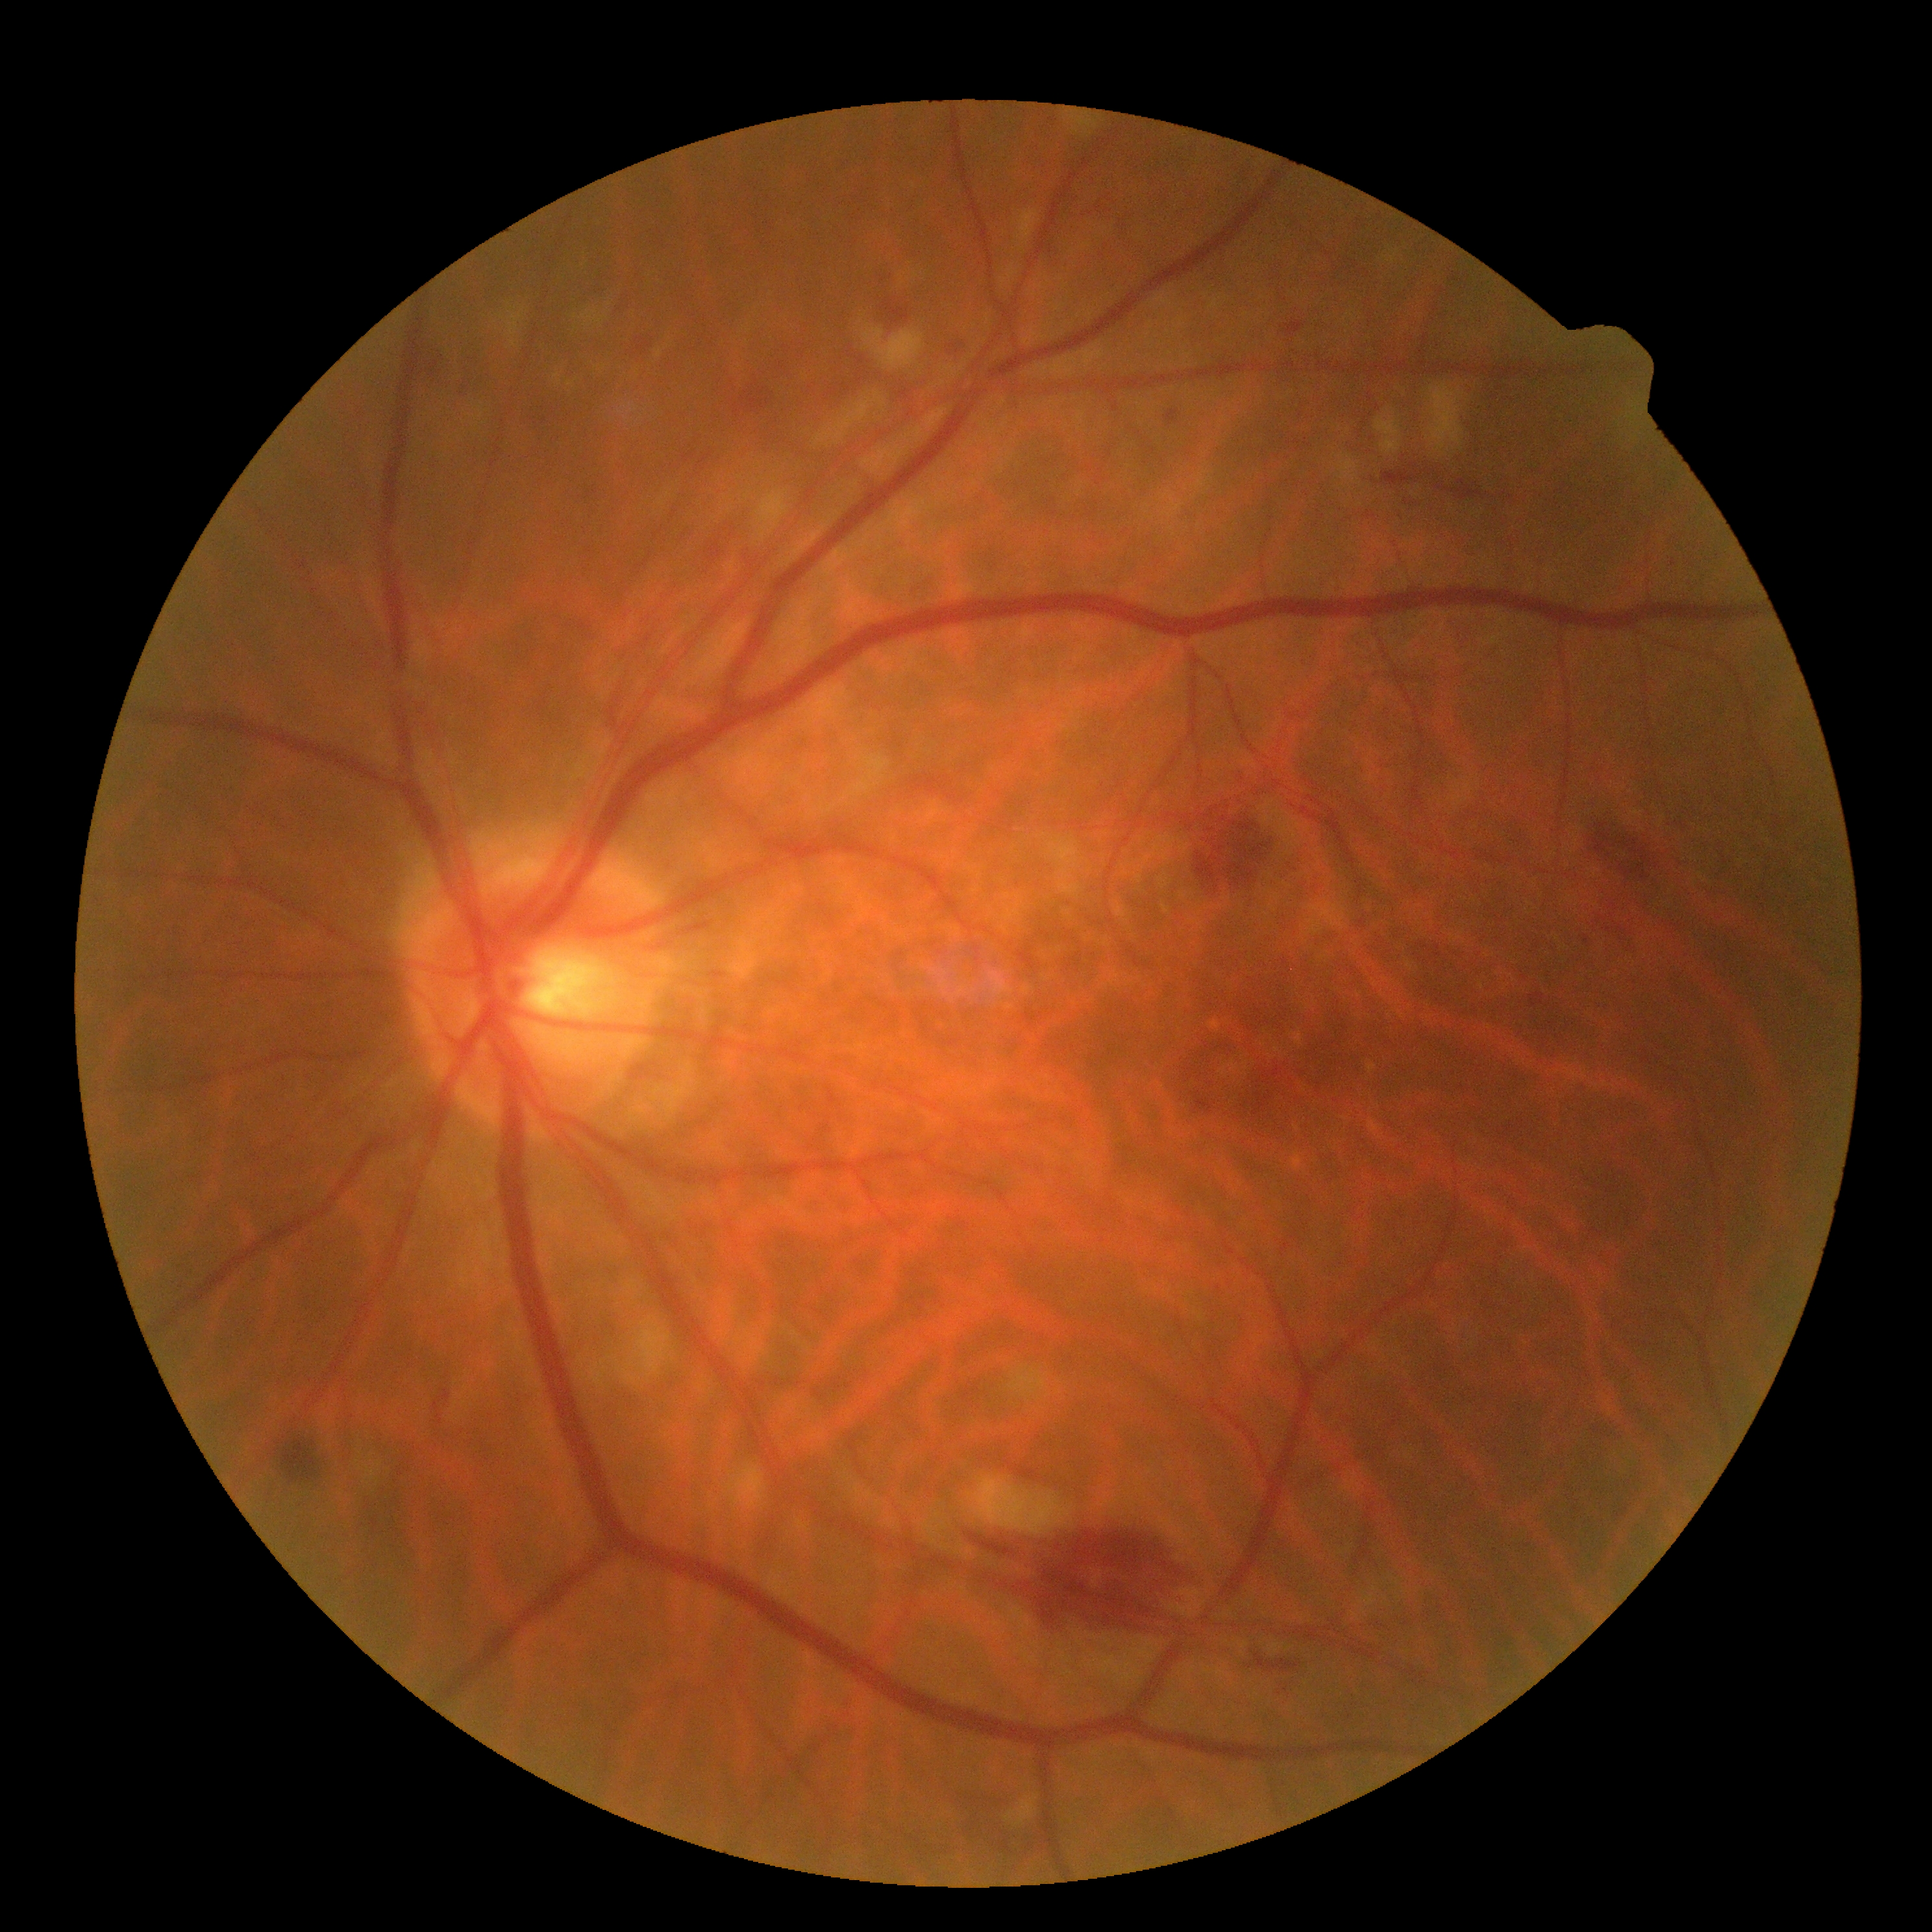

DR stage: moderate NPDR (grade 2).